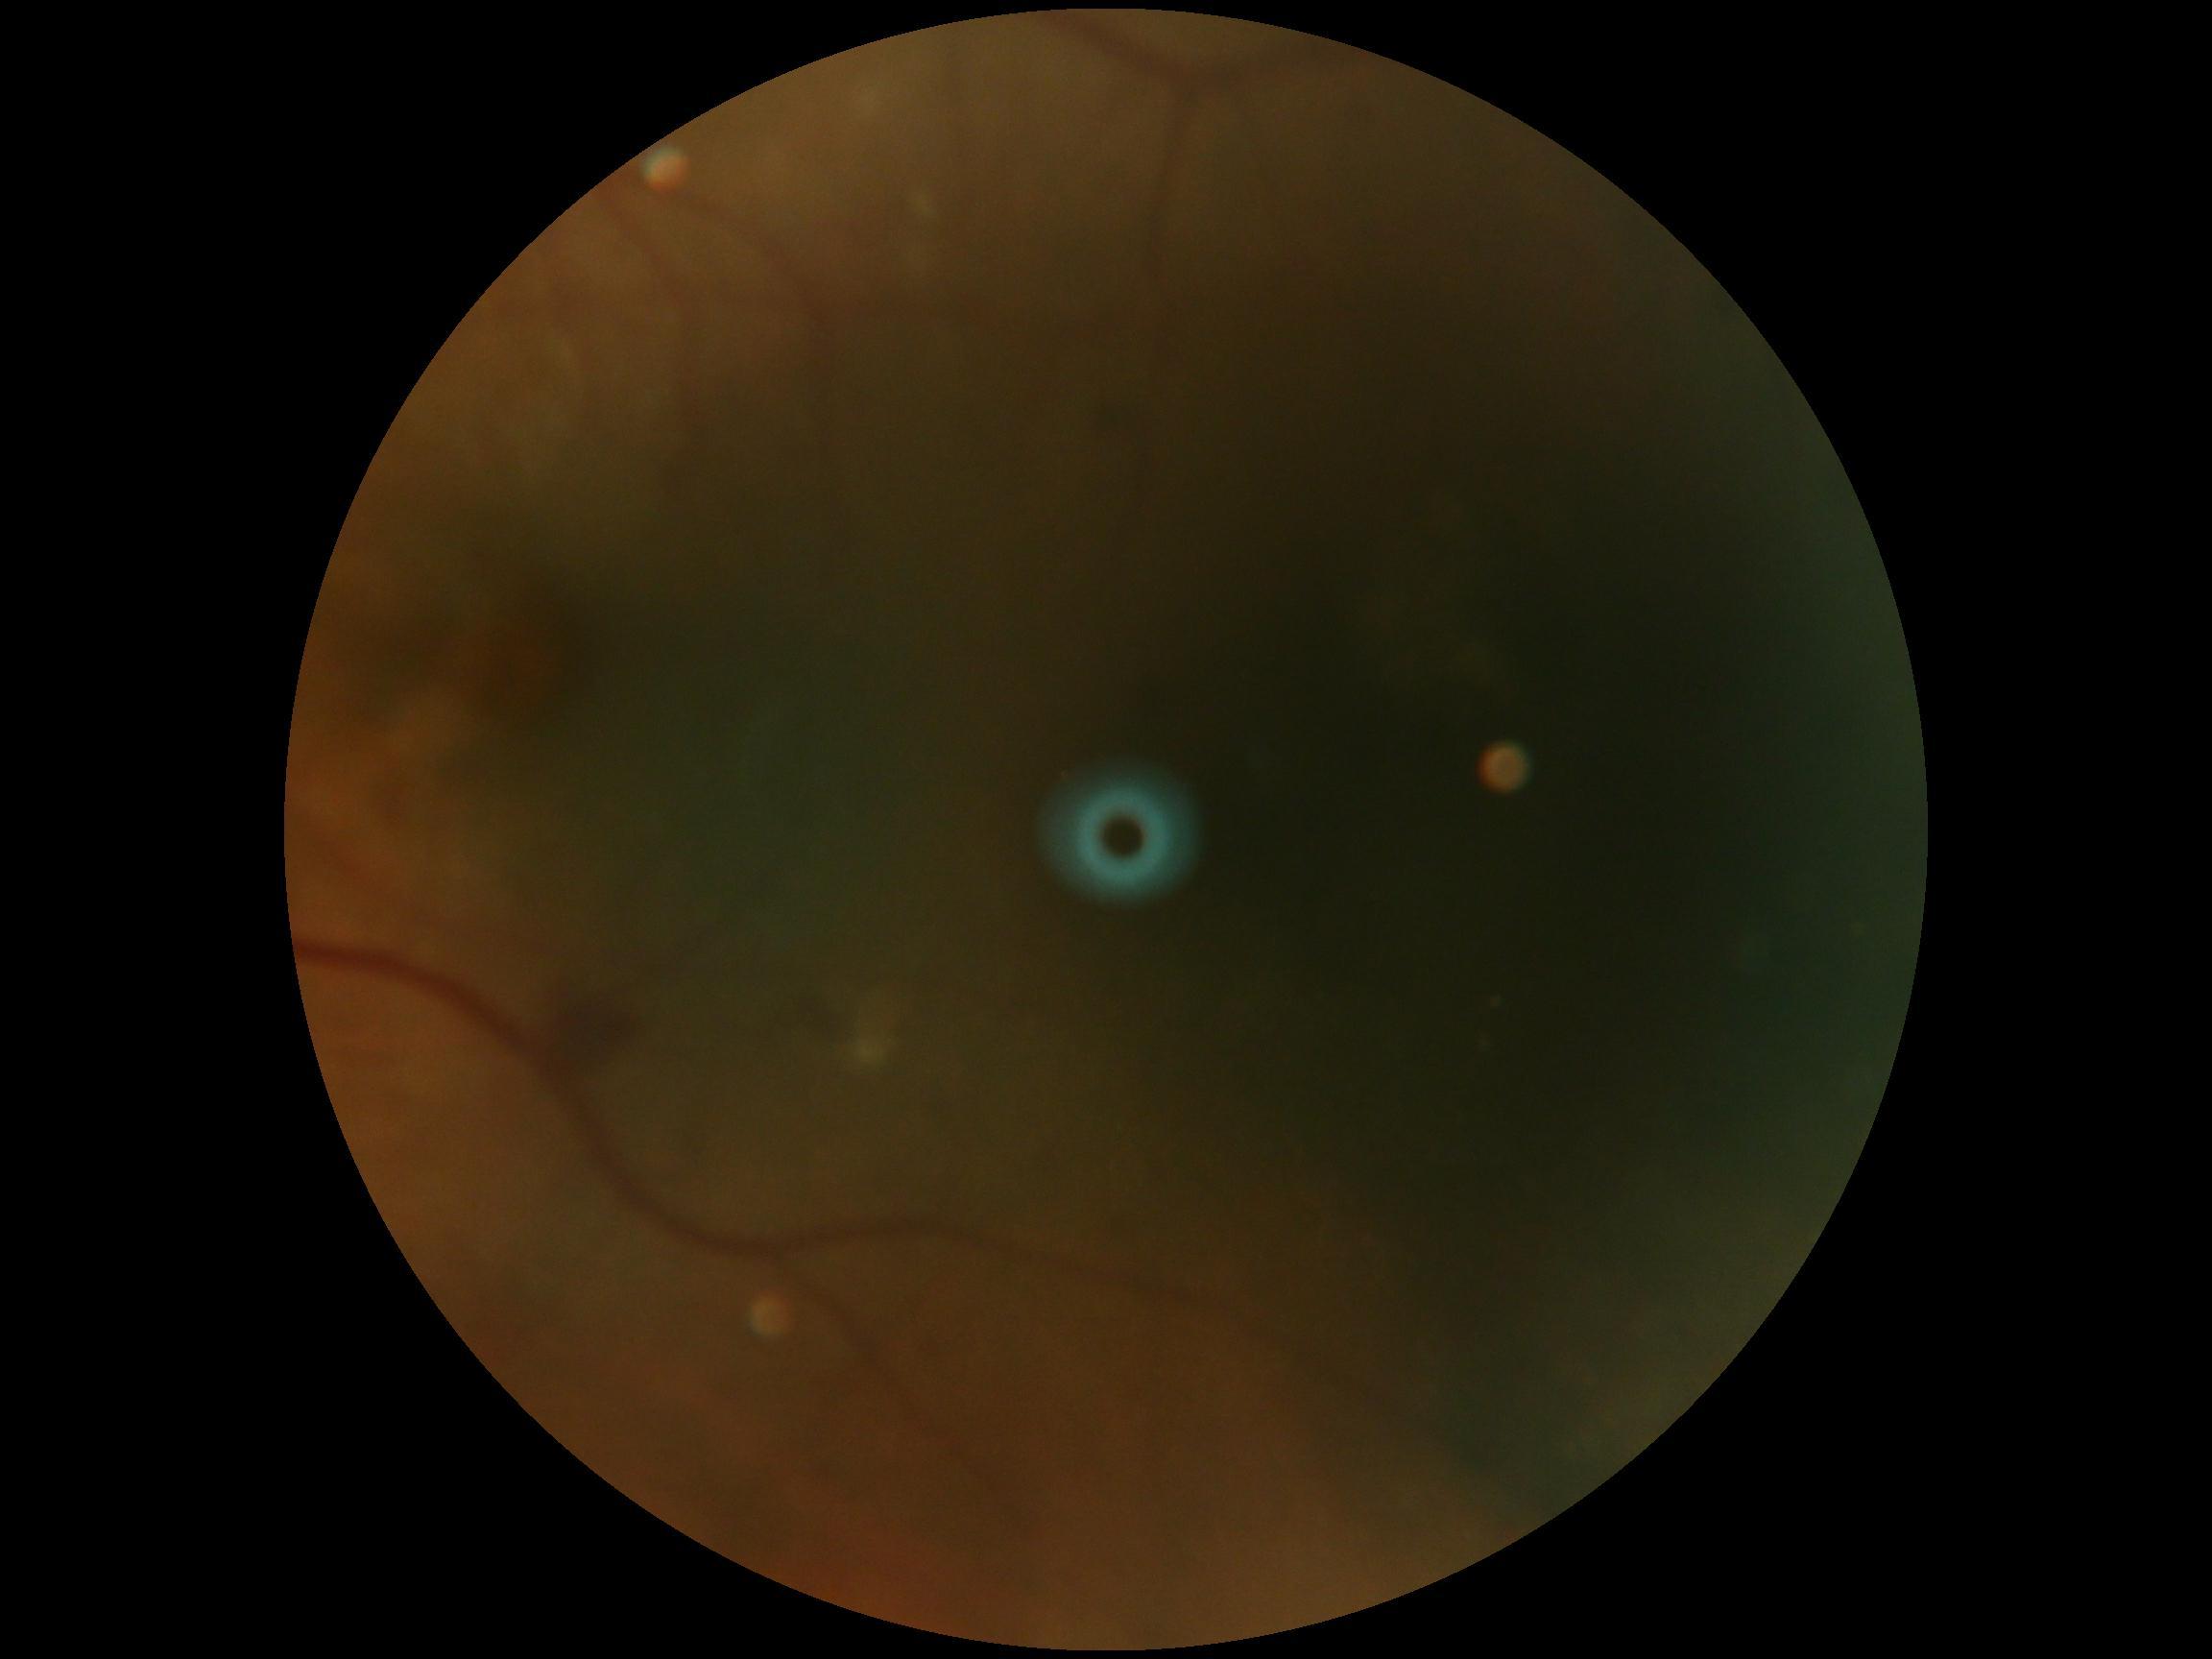
DR grade = 2/4.